Centered on the macula — 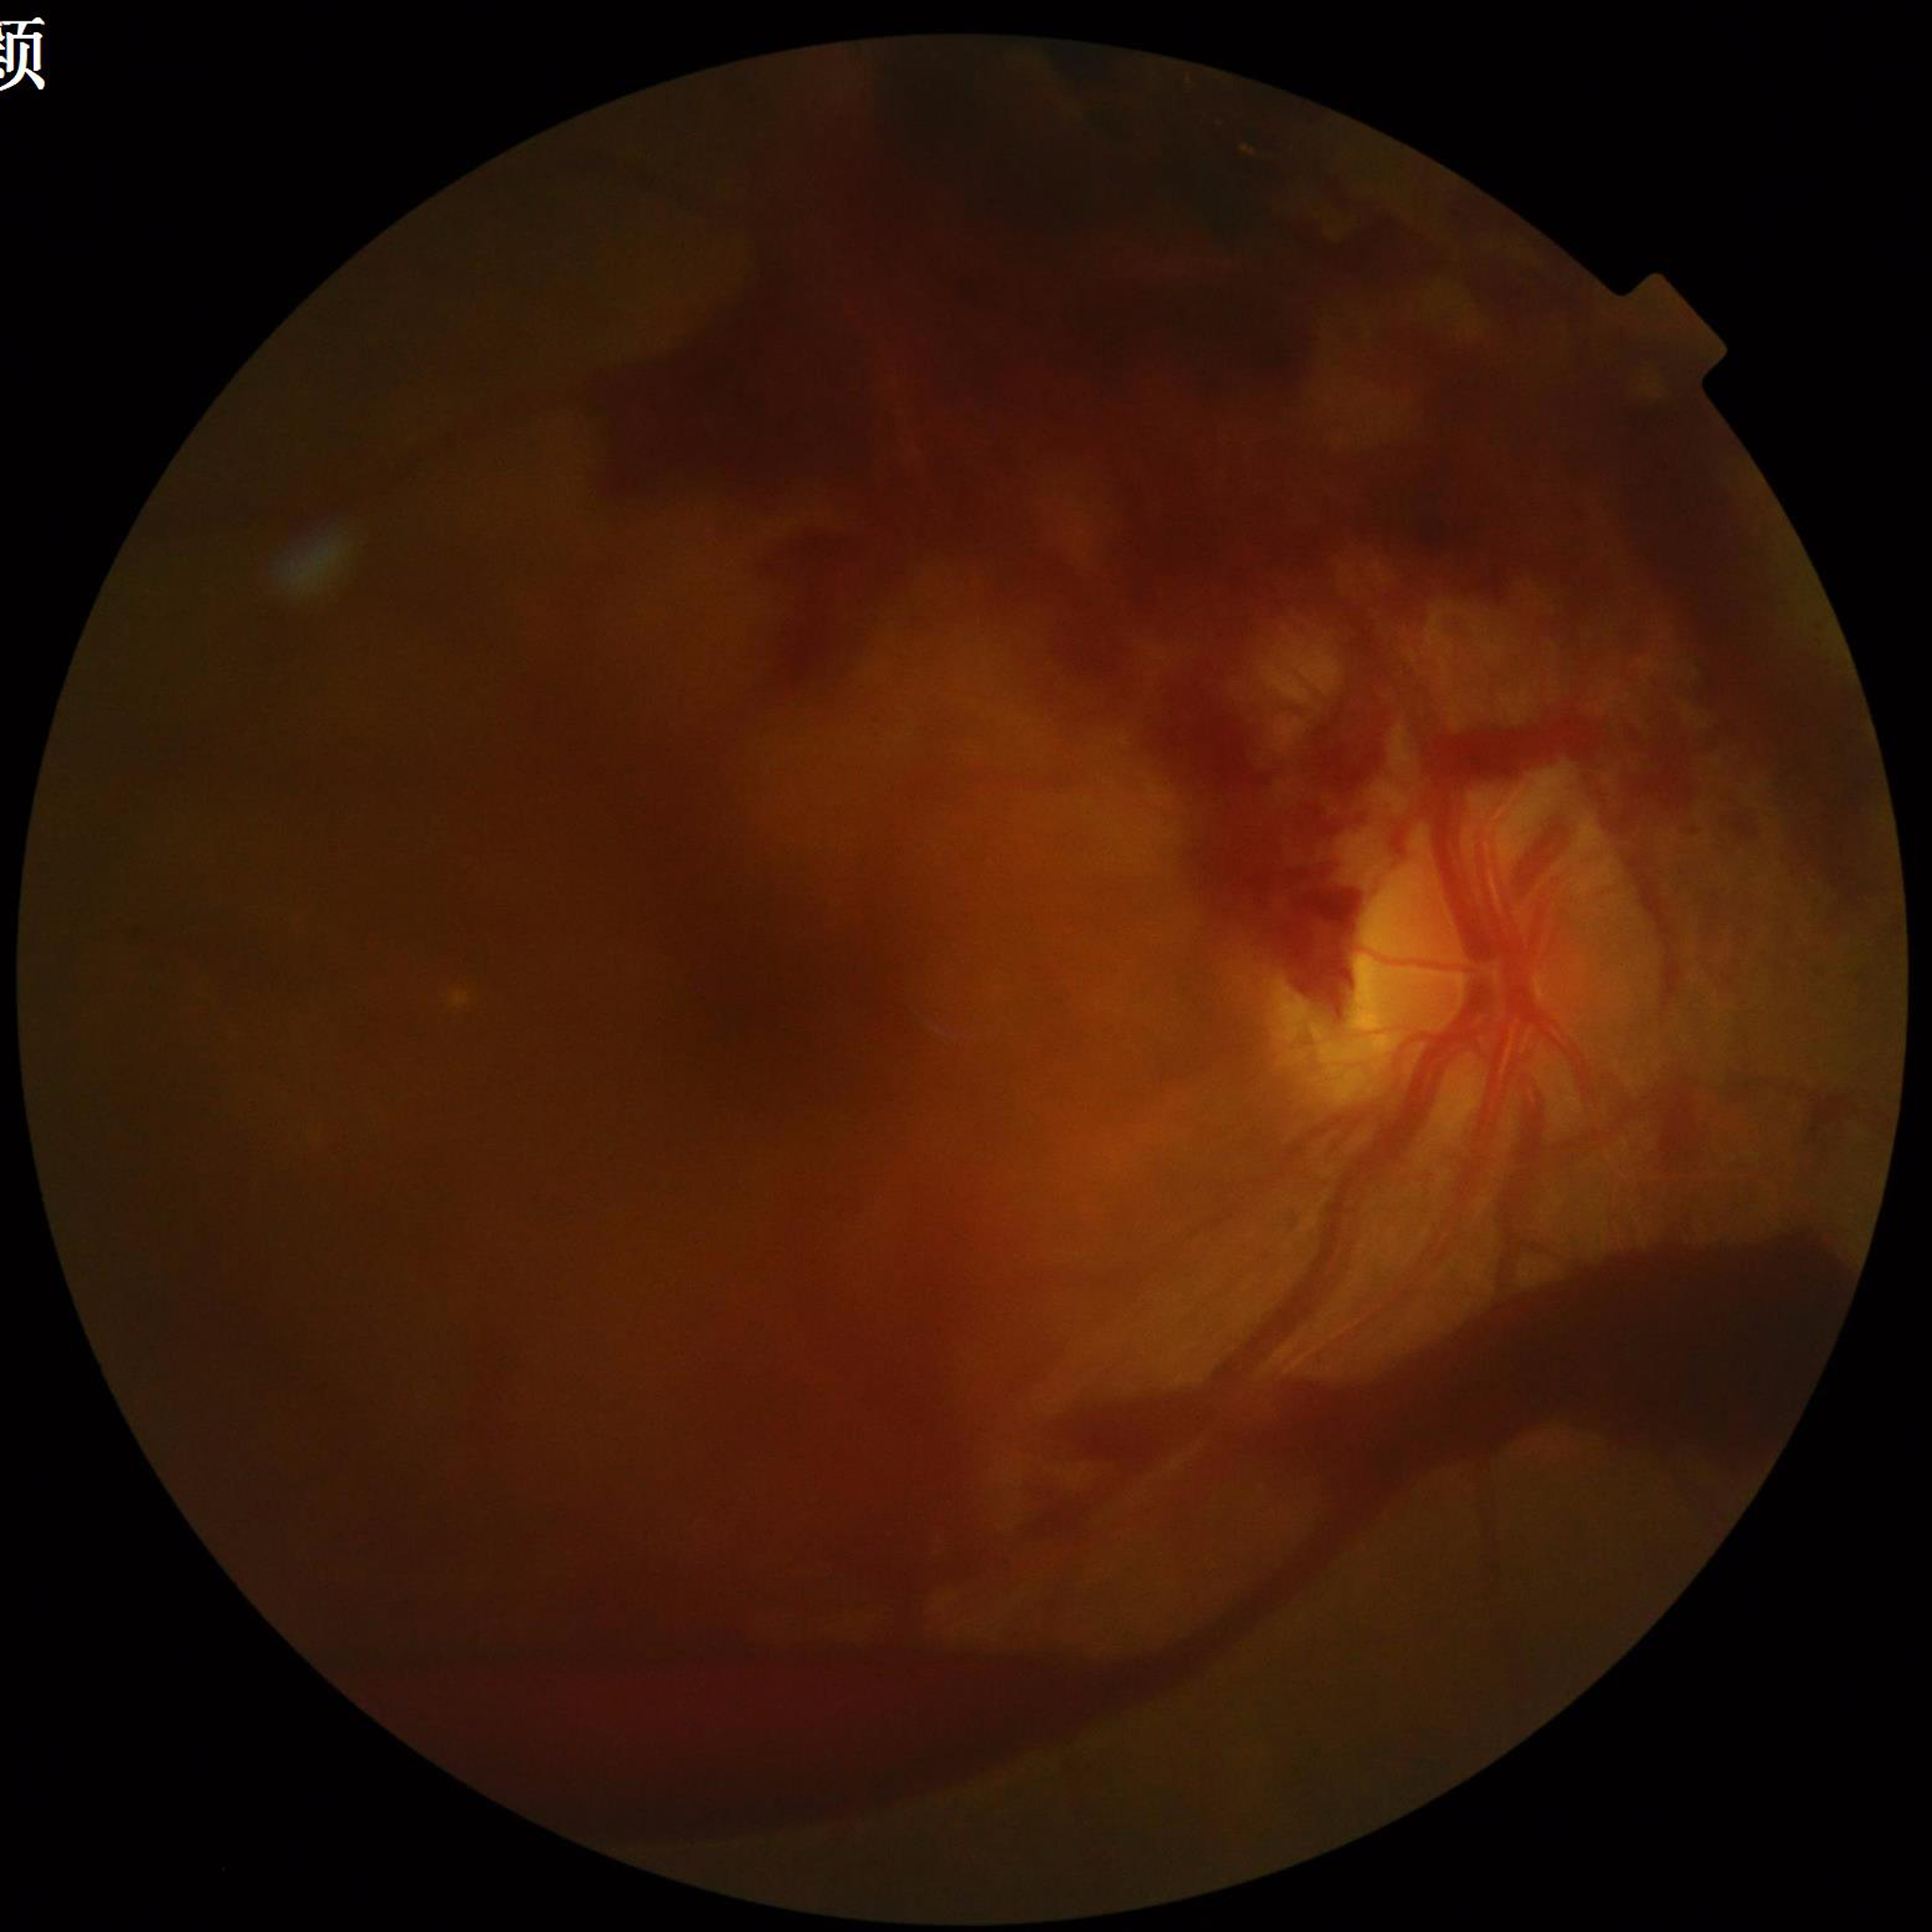
Photo quality: issues noted — blur, illumination/color distortion, low contrast; Clinical diagnosis: DR.